45-degree field of view
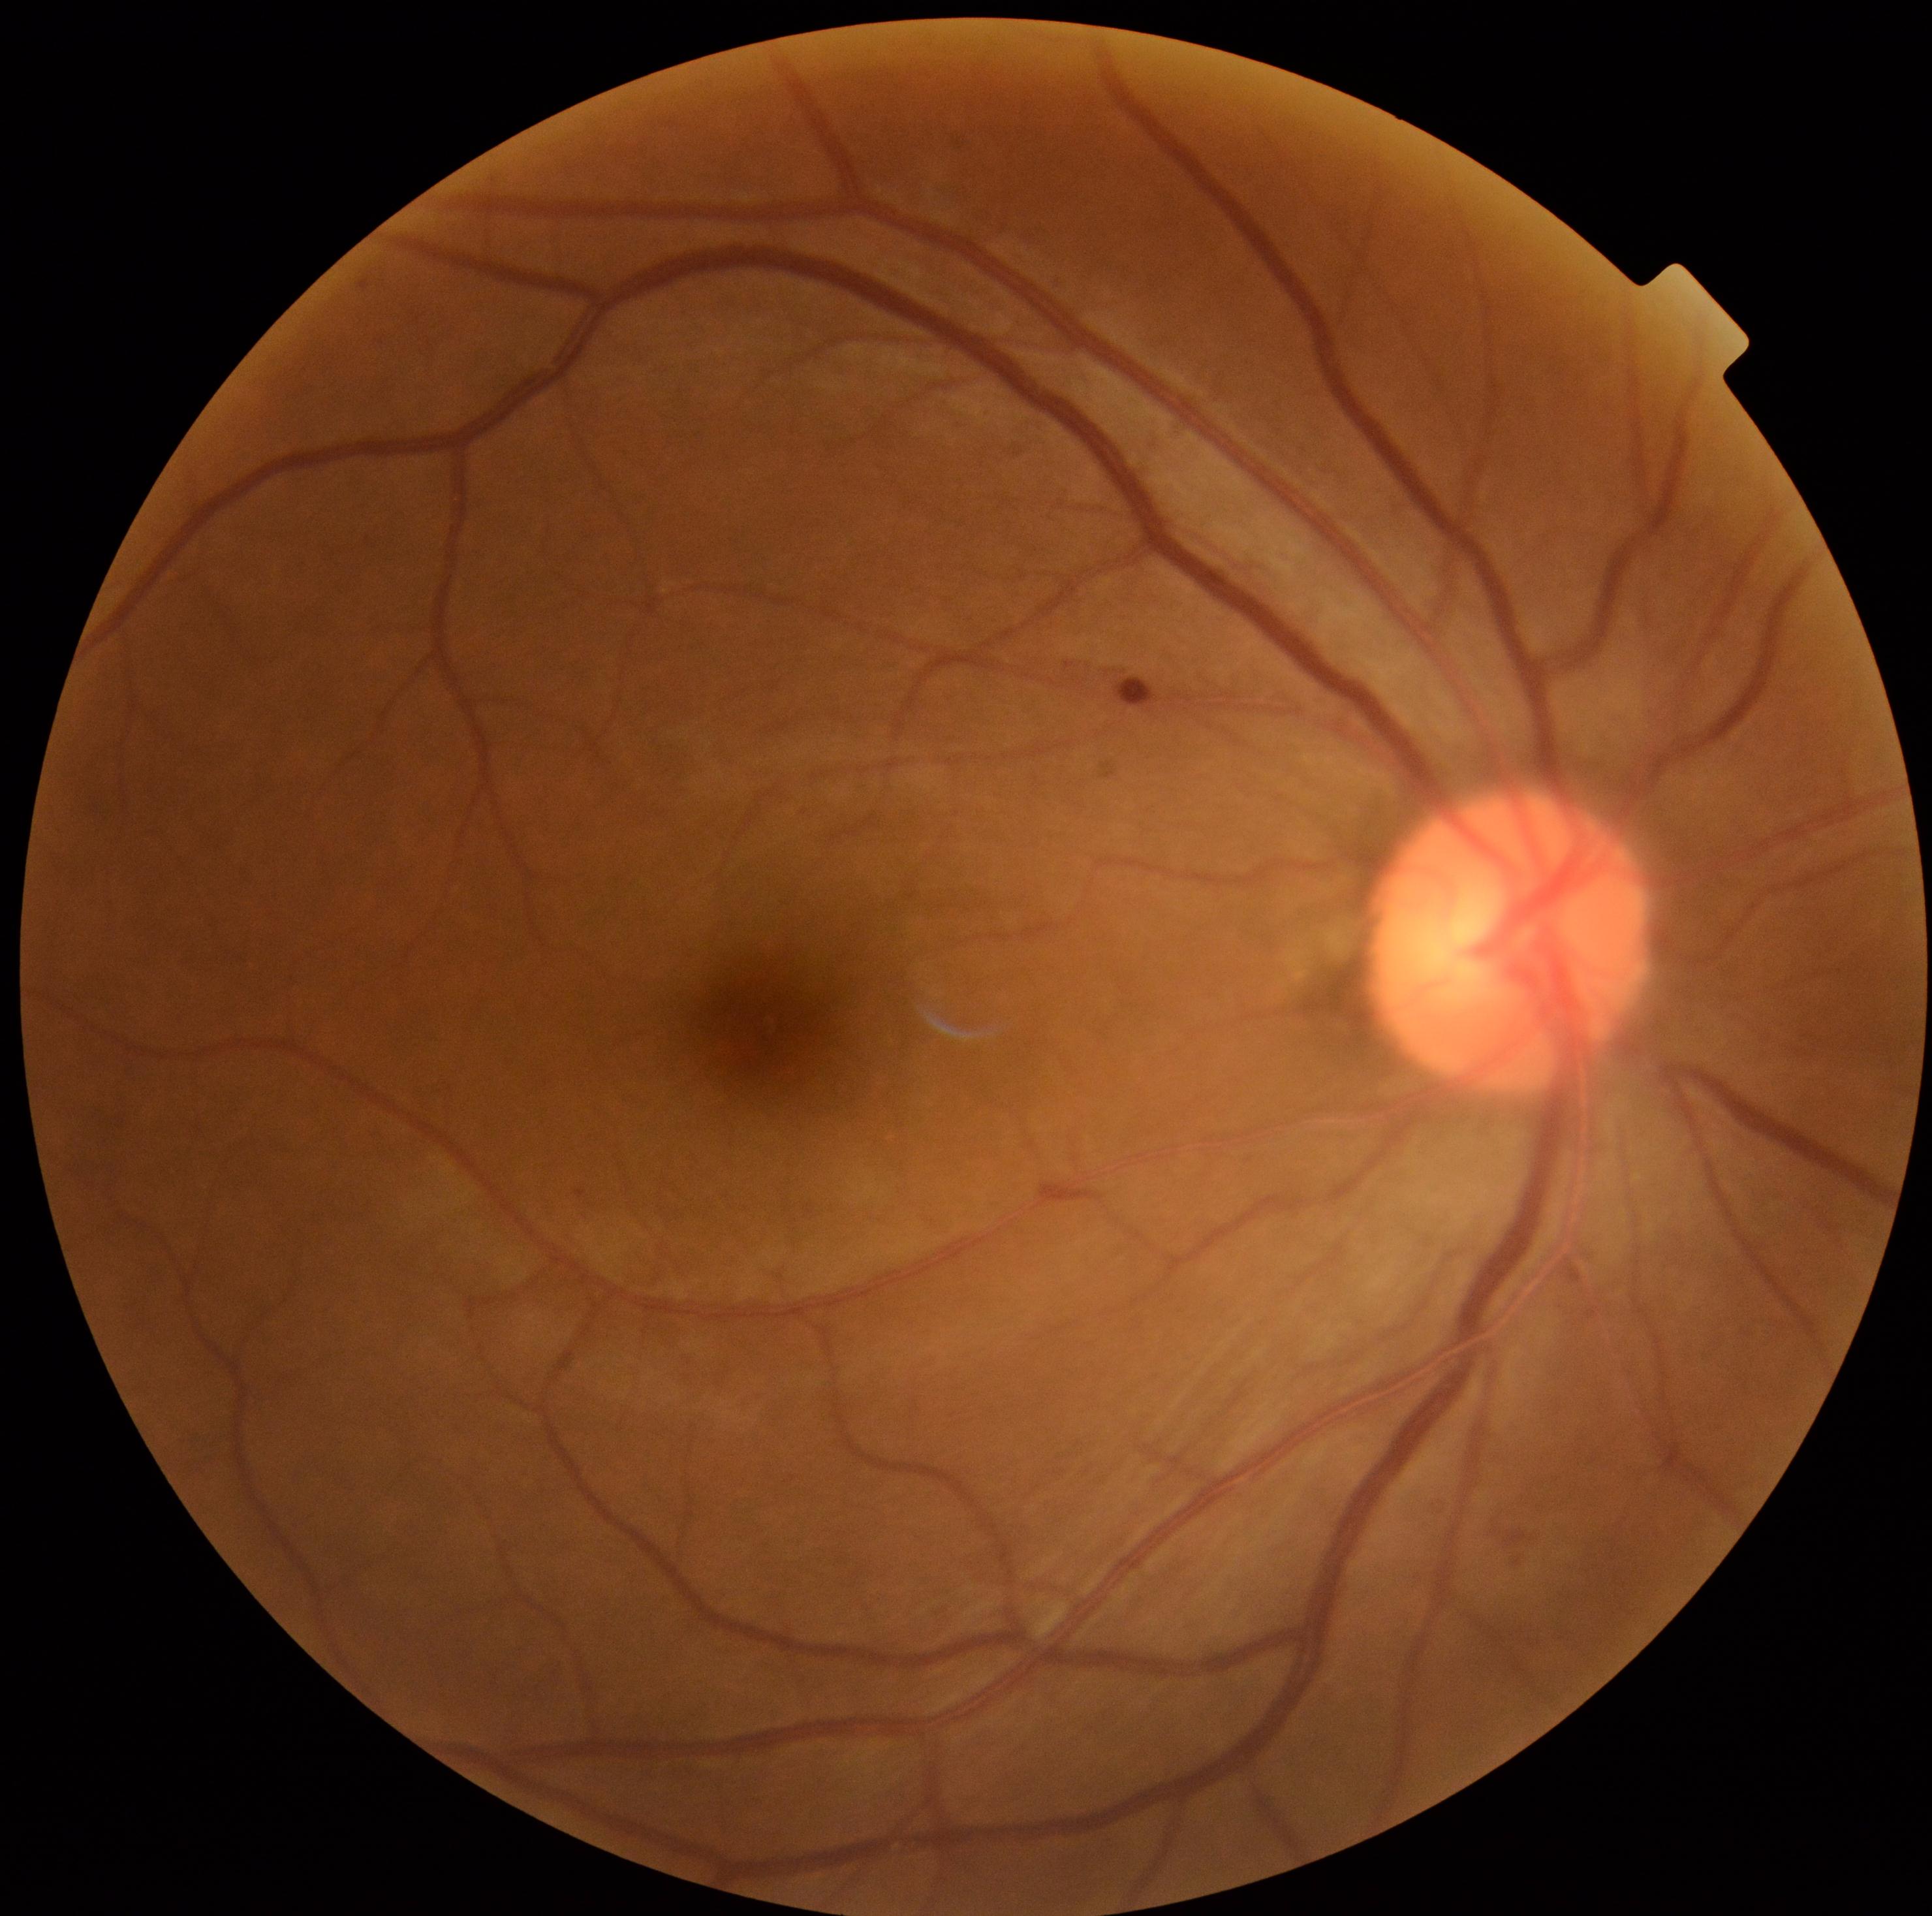

Diabetic retinopathy grade: 2 (moderate NPDR)
hemorrhages = <region>1115, 679, 1160, 709</region> | <region>1504, 1530, 1527, 1547</region>
soft exudates = absent
microaneurysms = <region>576, 1191, 585, 1197</region>
Additional small microaneurysms near Point(1518, 1562)
hard exudates = absent